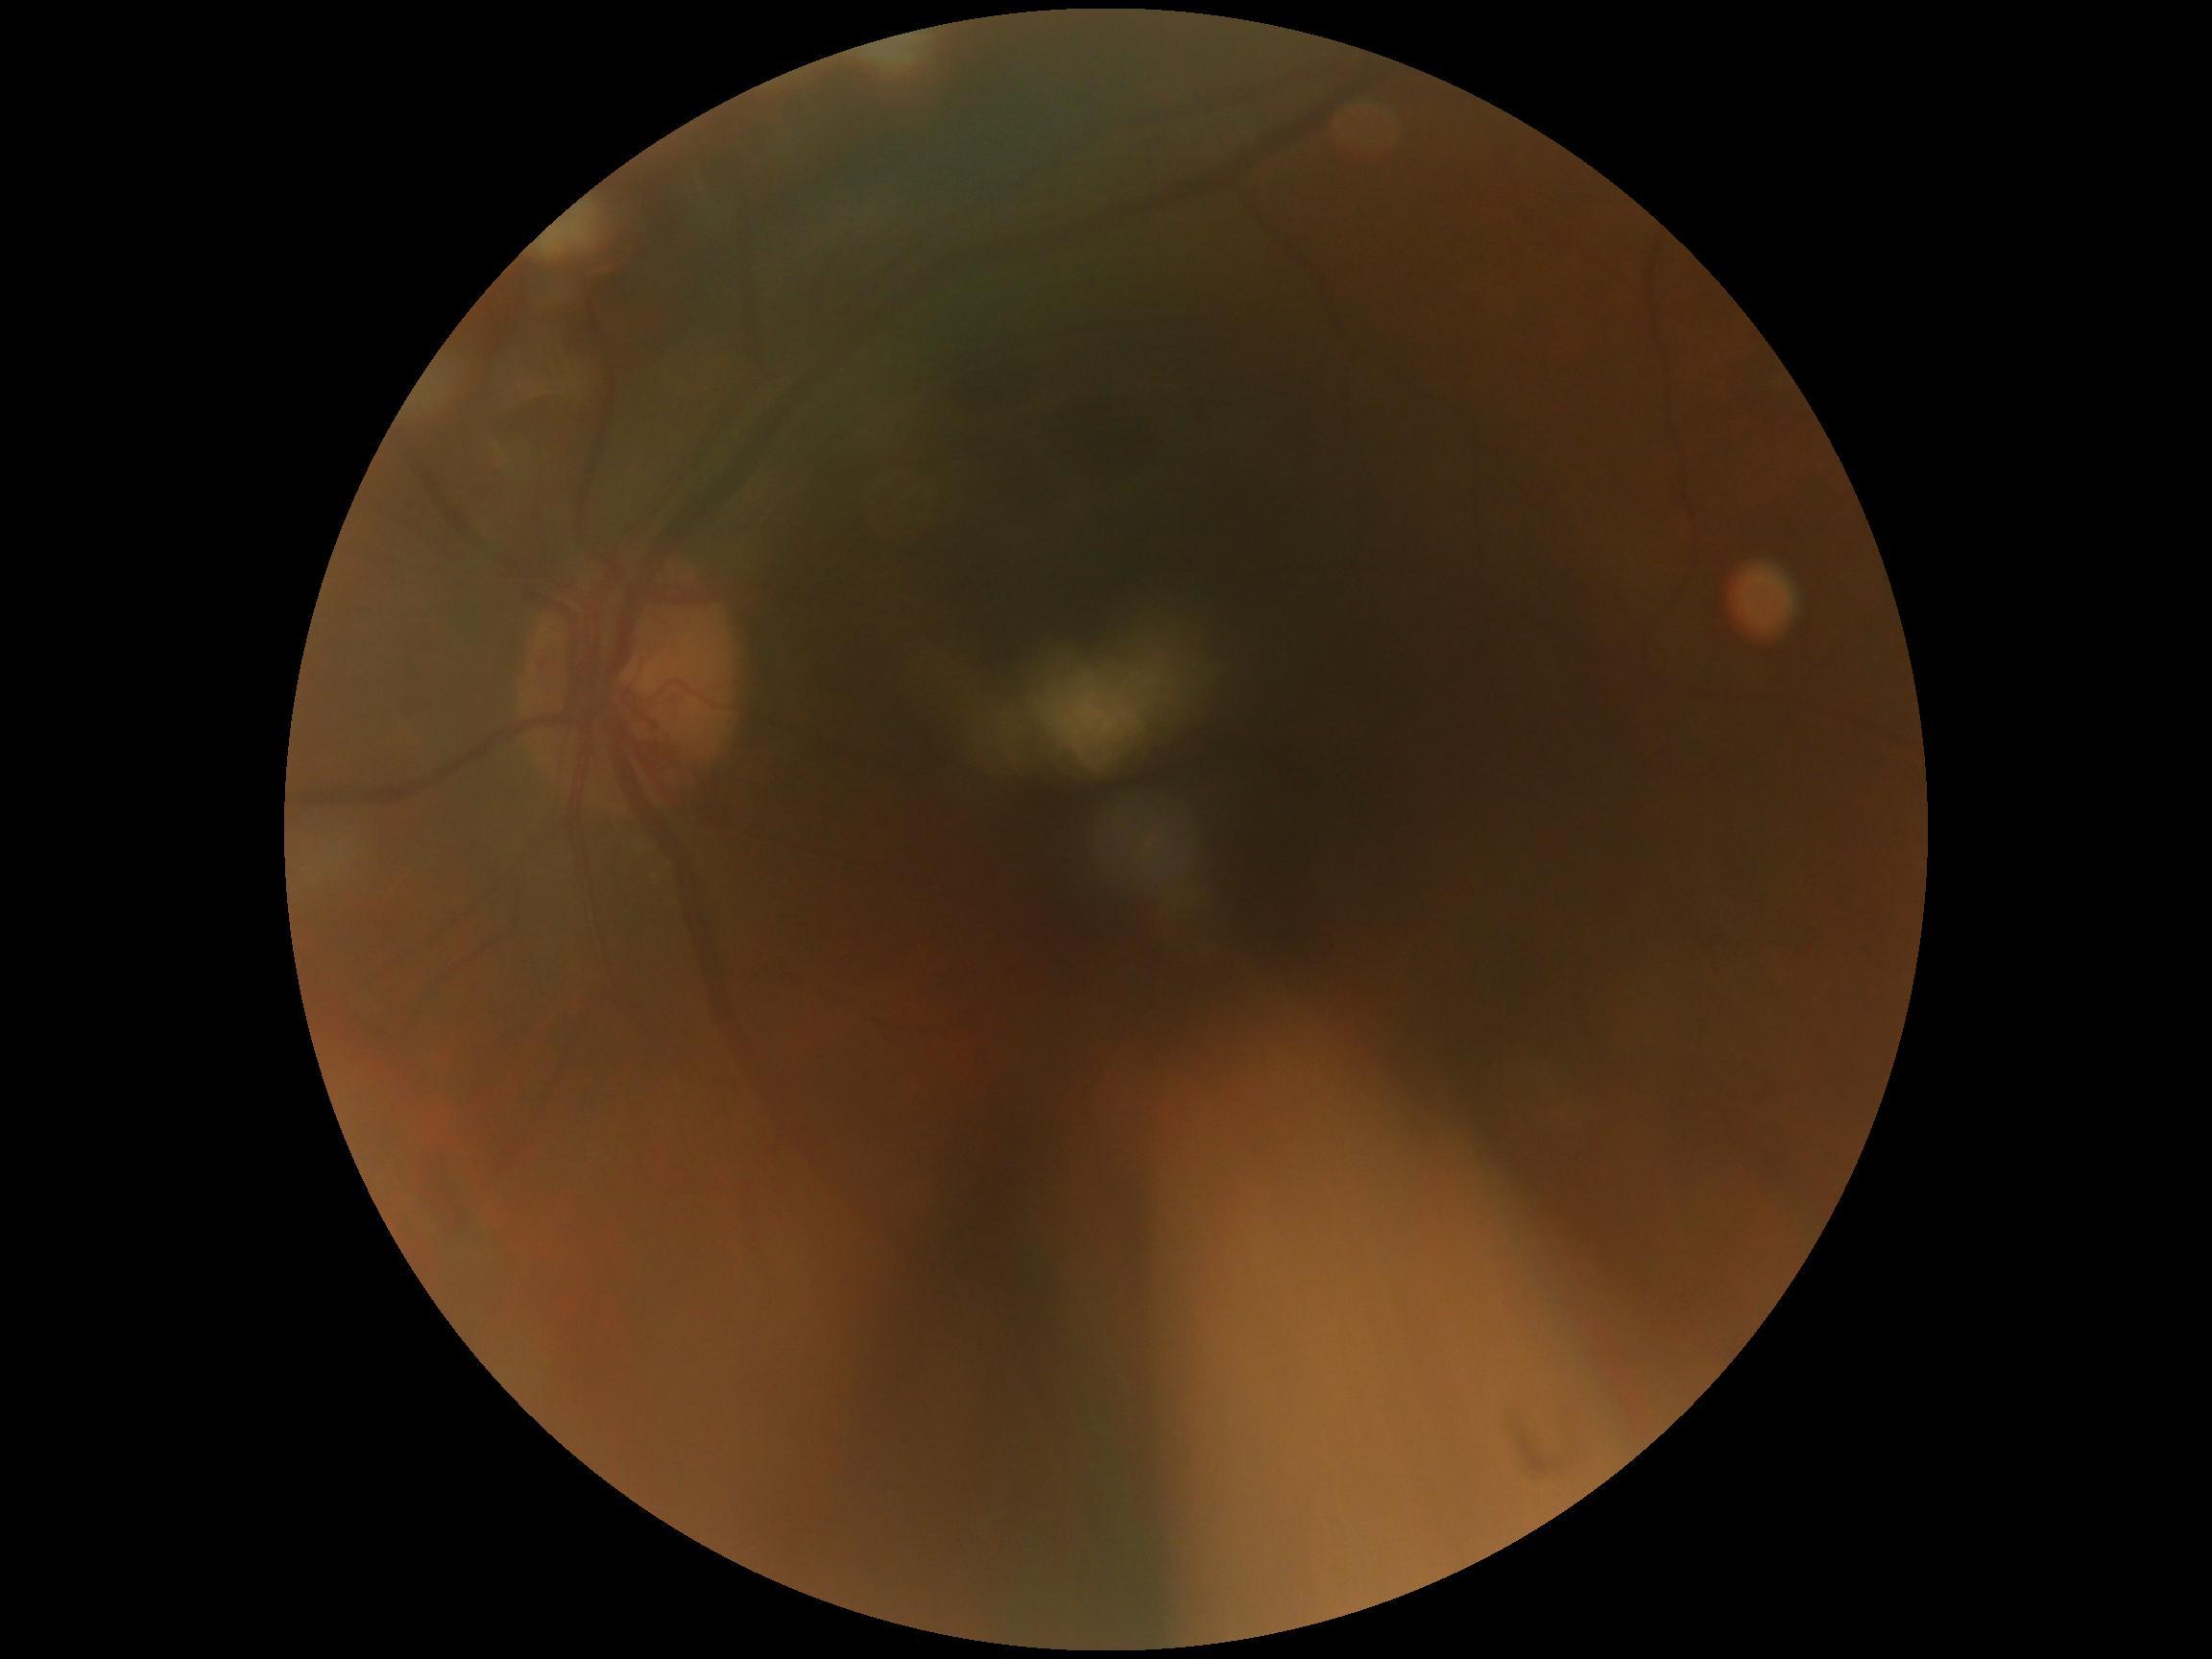

DR: grade 0.